Davis DR grading · FOV: 45 degrees · 848 by 848 pixels · NIDEK AFC-230 fundus camera: 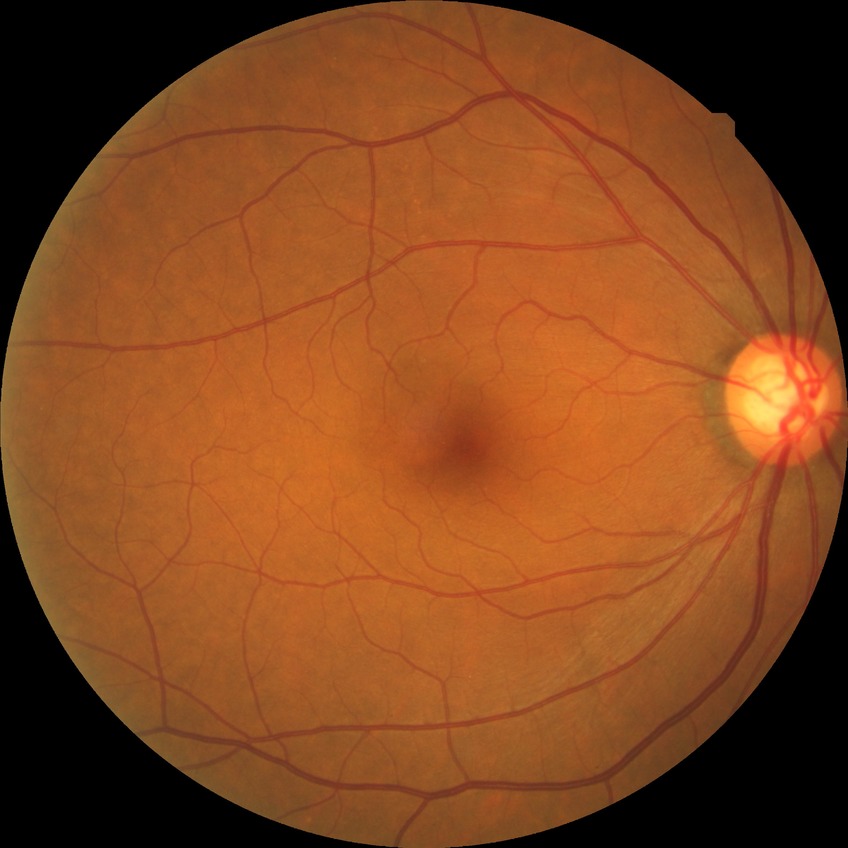 diabetic retinopathy (DR)@no diabetic retinopathy (NDR).